Color fundus image, image size 848x848
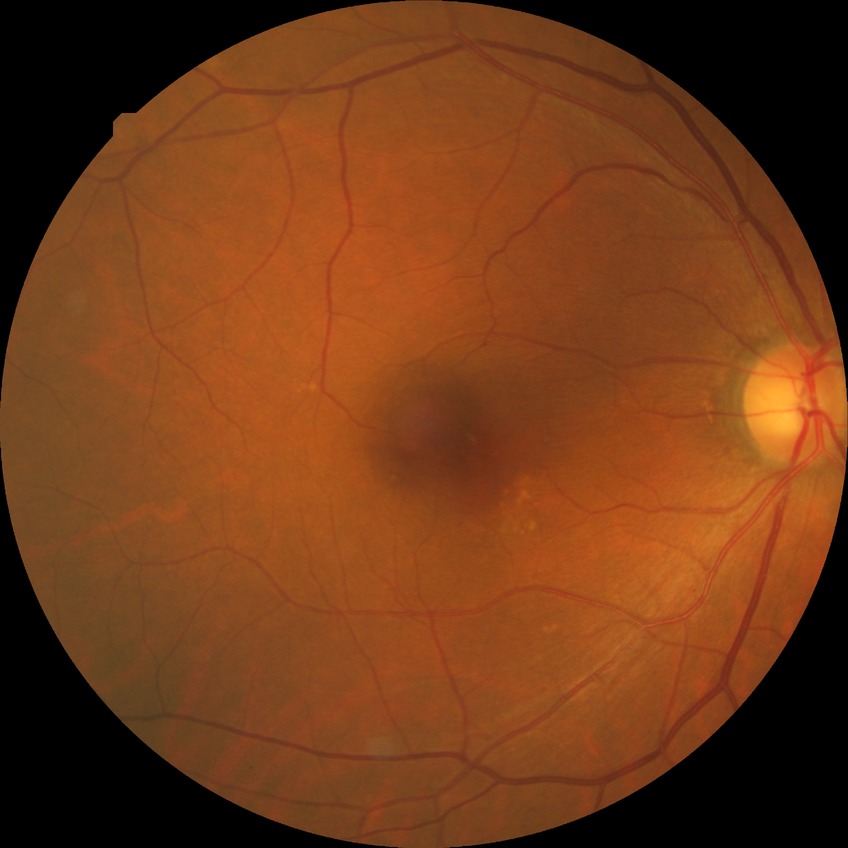

{
  "davis_grade": "no diabetic retinopathy"
}